Ultra-widefield fundus photograph:
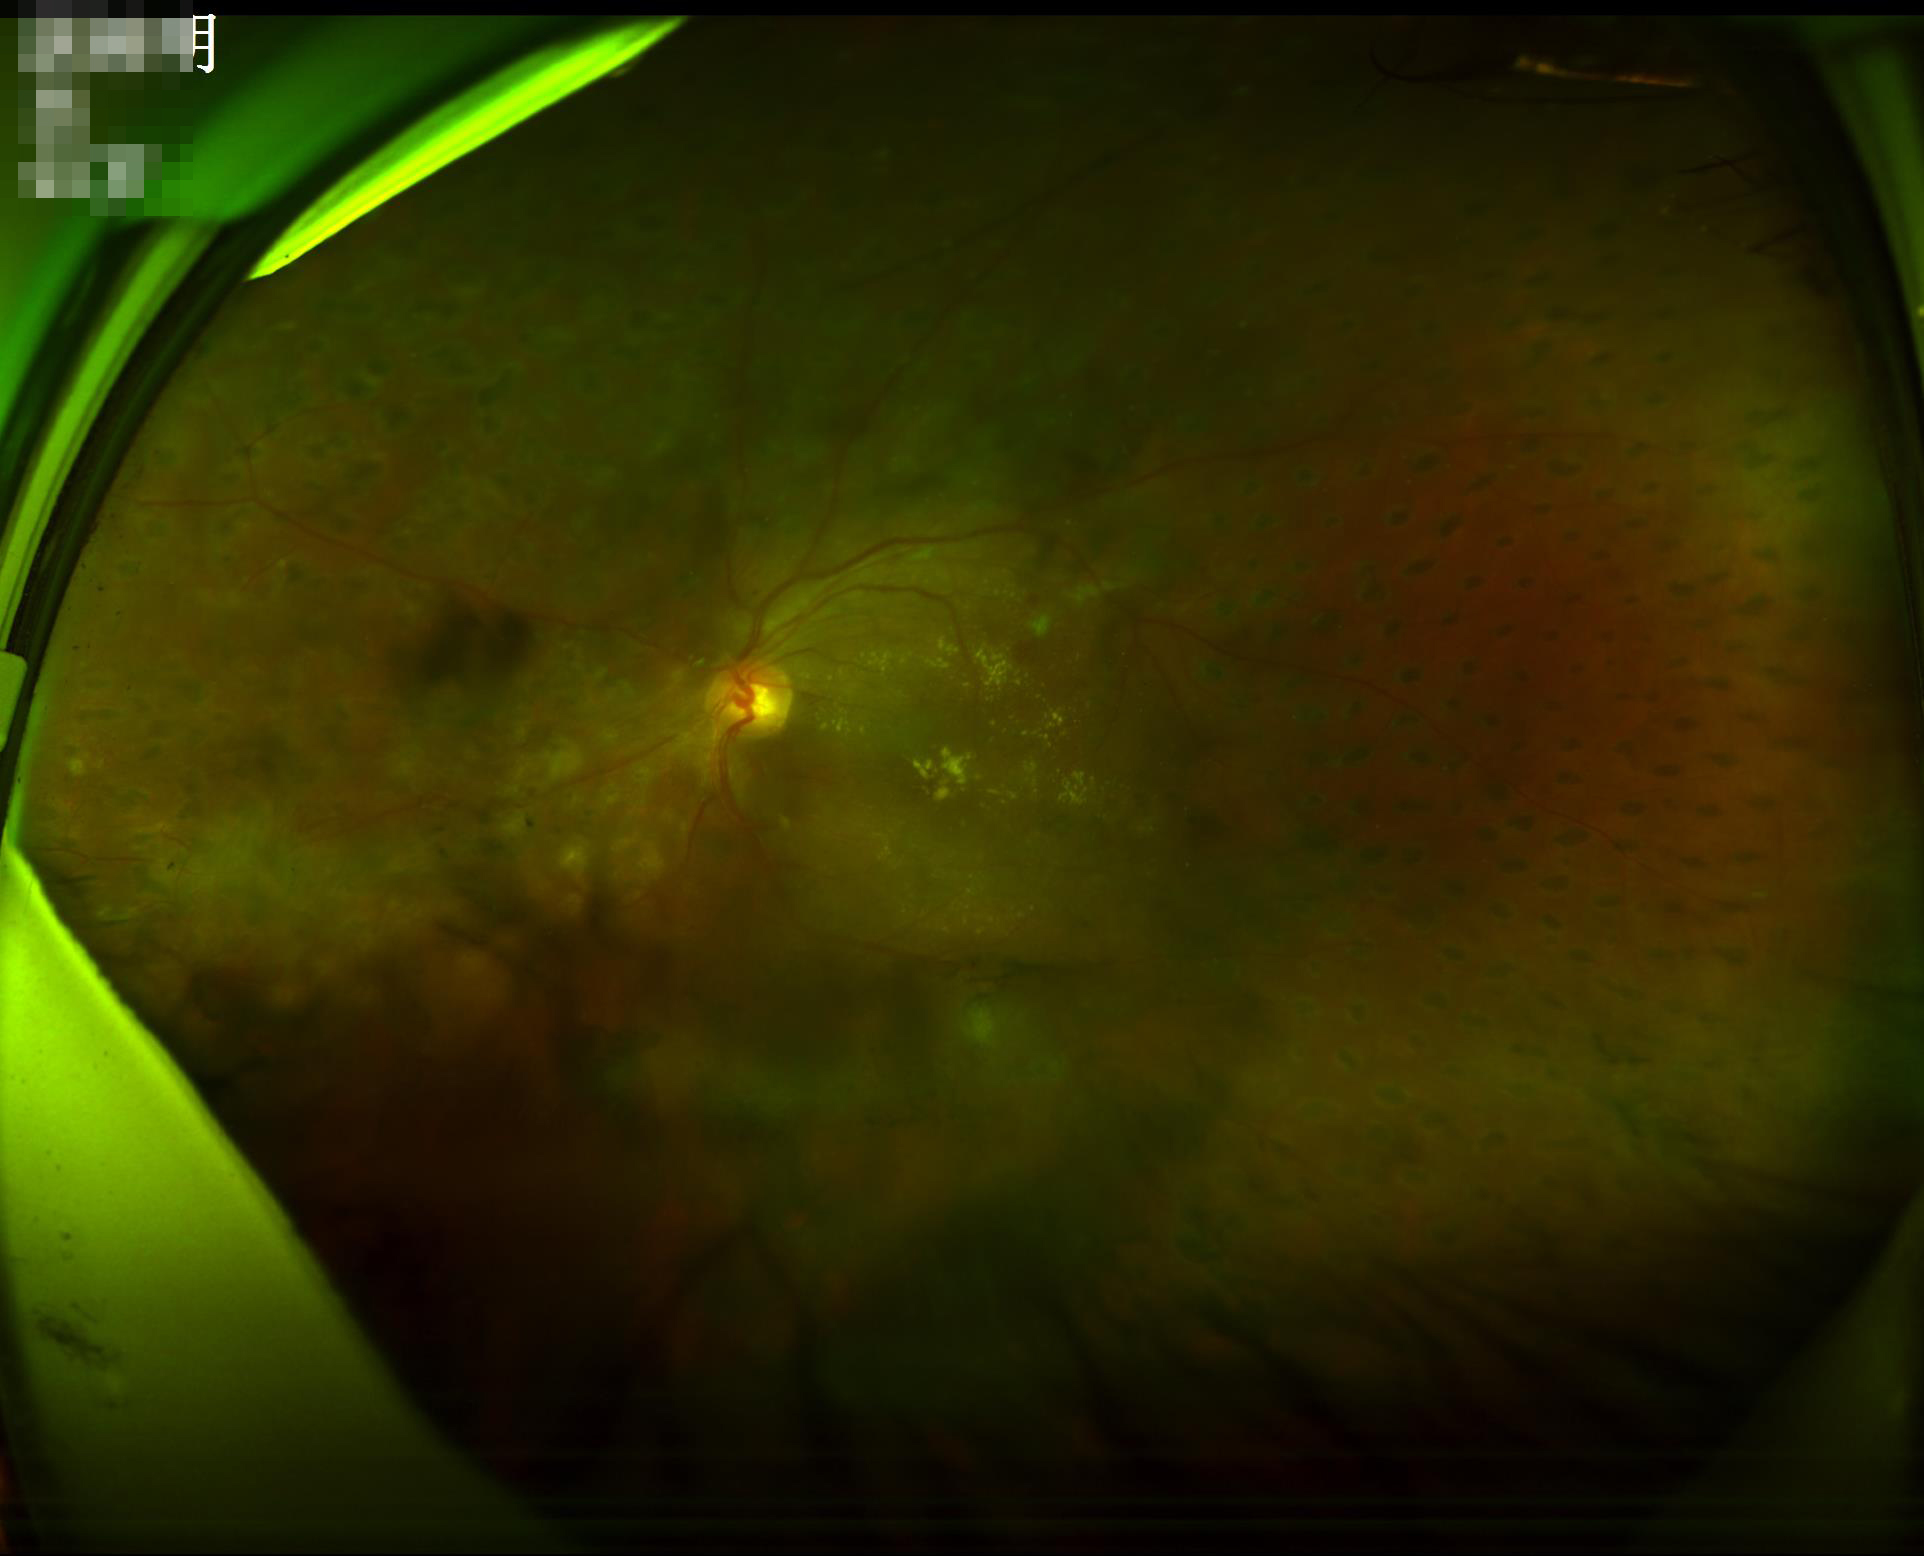 Illumination/color = inadequate, with uneven exposure or color distortion; Overall image quality = inadequate for clinical interpretation; Contrast = good dynamic range; Focus = noticeable blur in the optic disc, vessels, or background.